1240x1240; infant wide-field retinal image; captured with the Phoenix ICON (100° field of view):
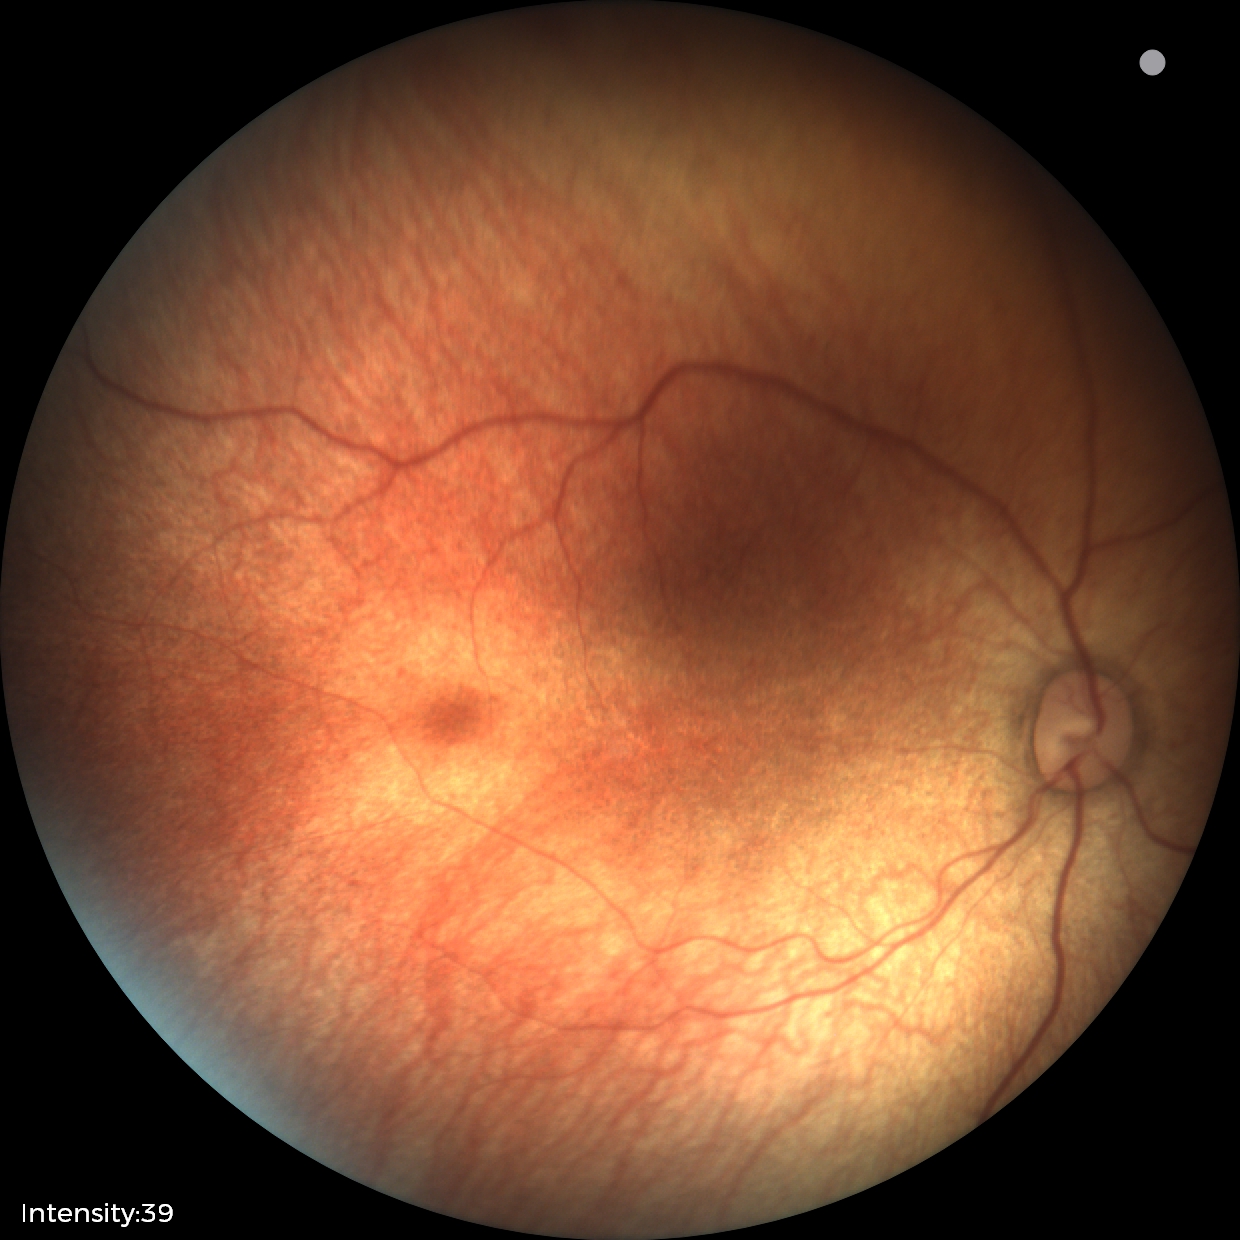
Impression: normal